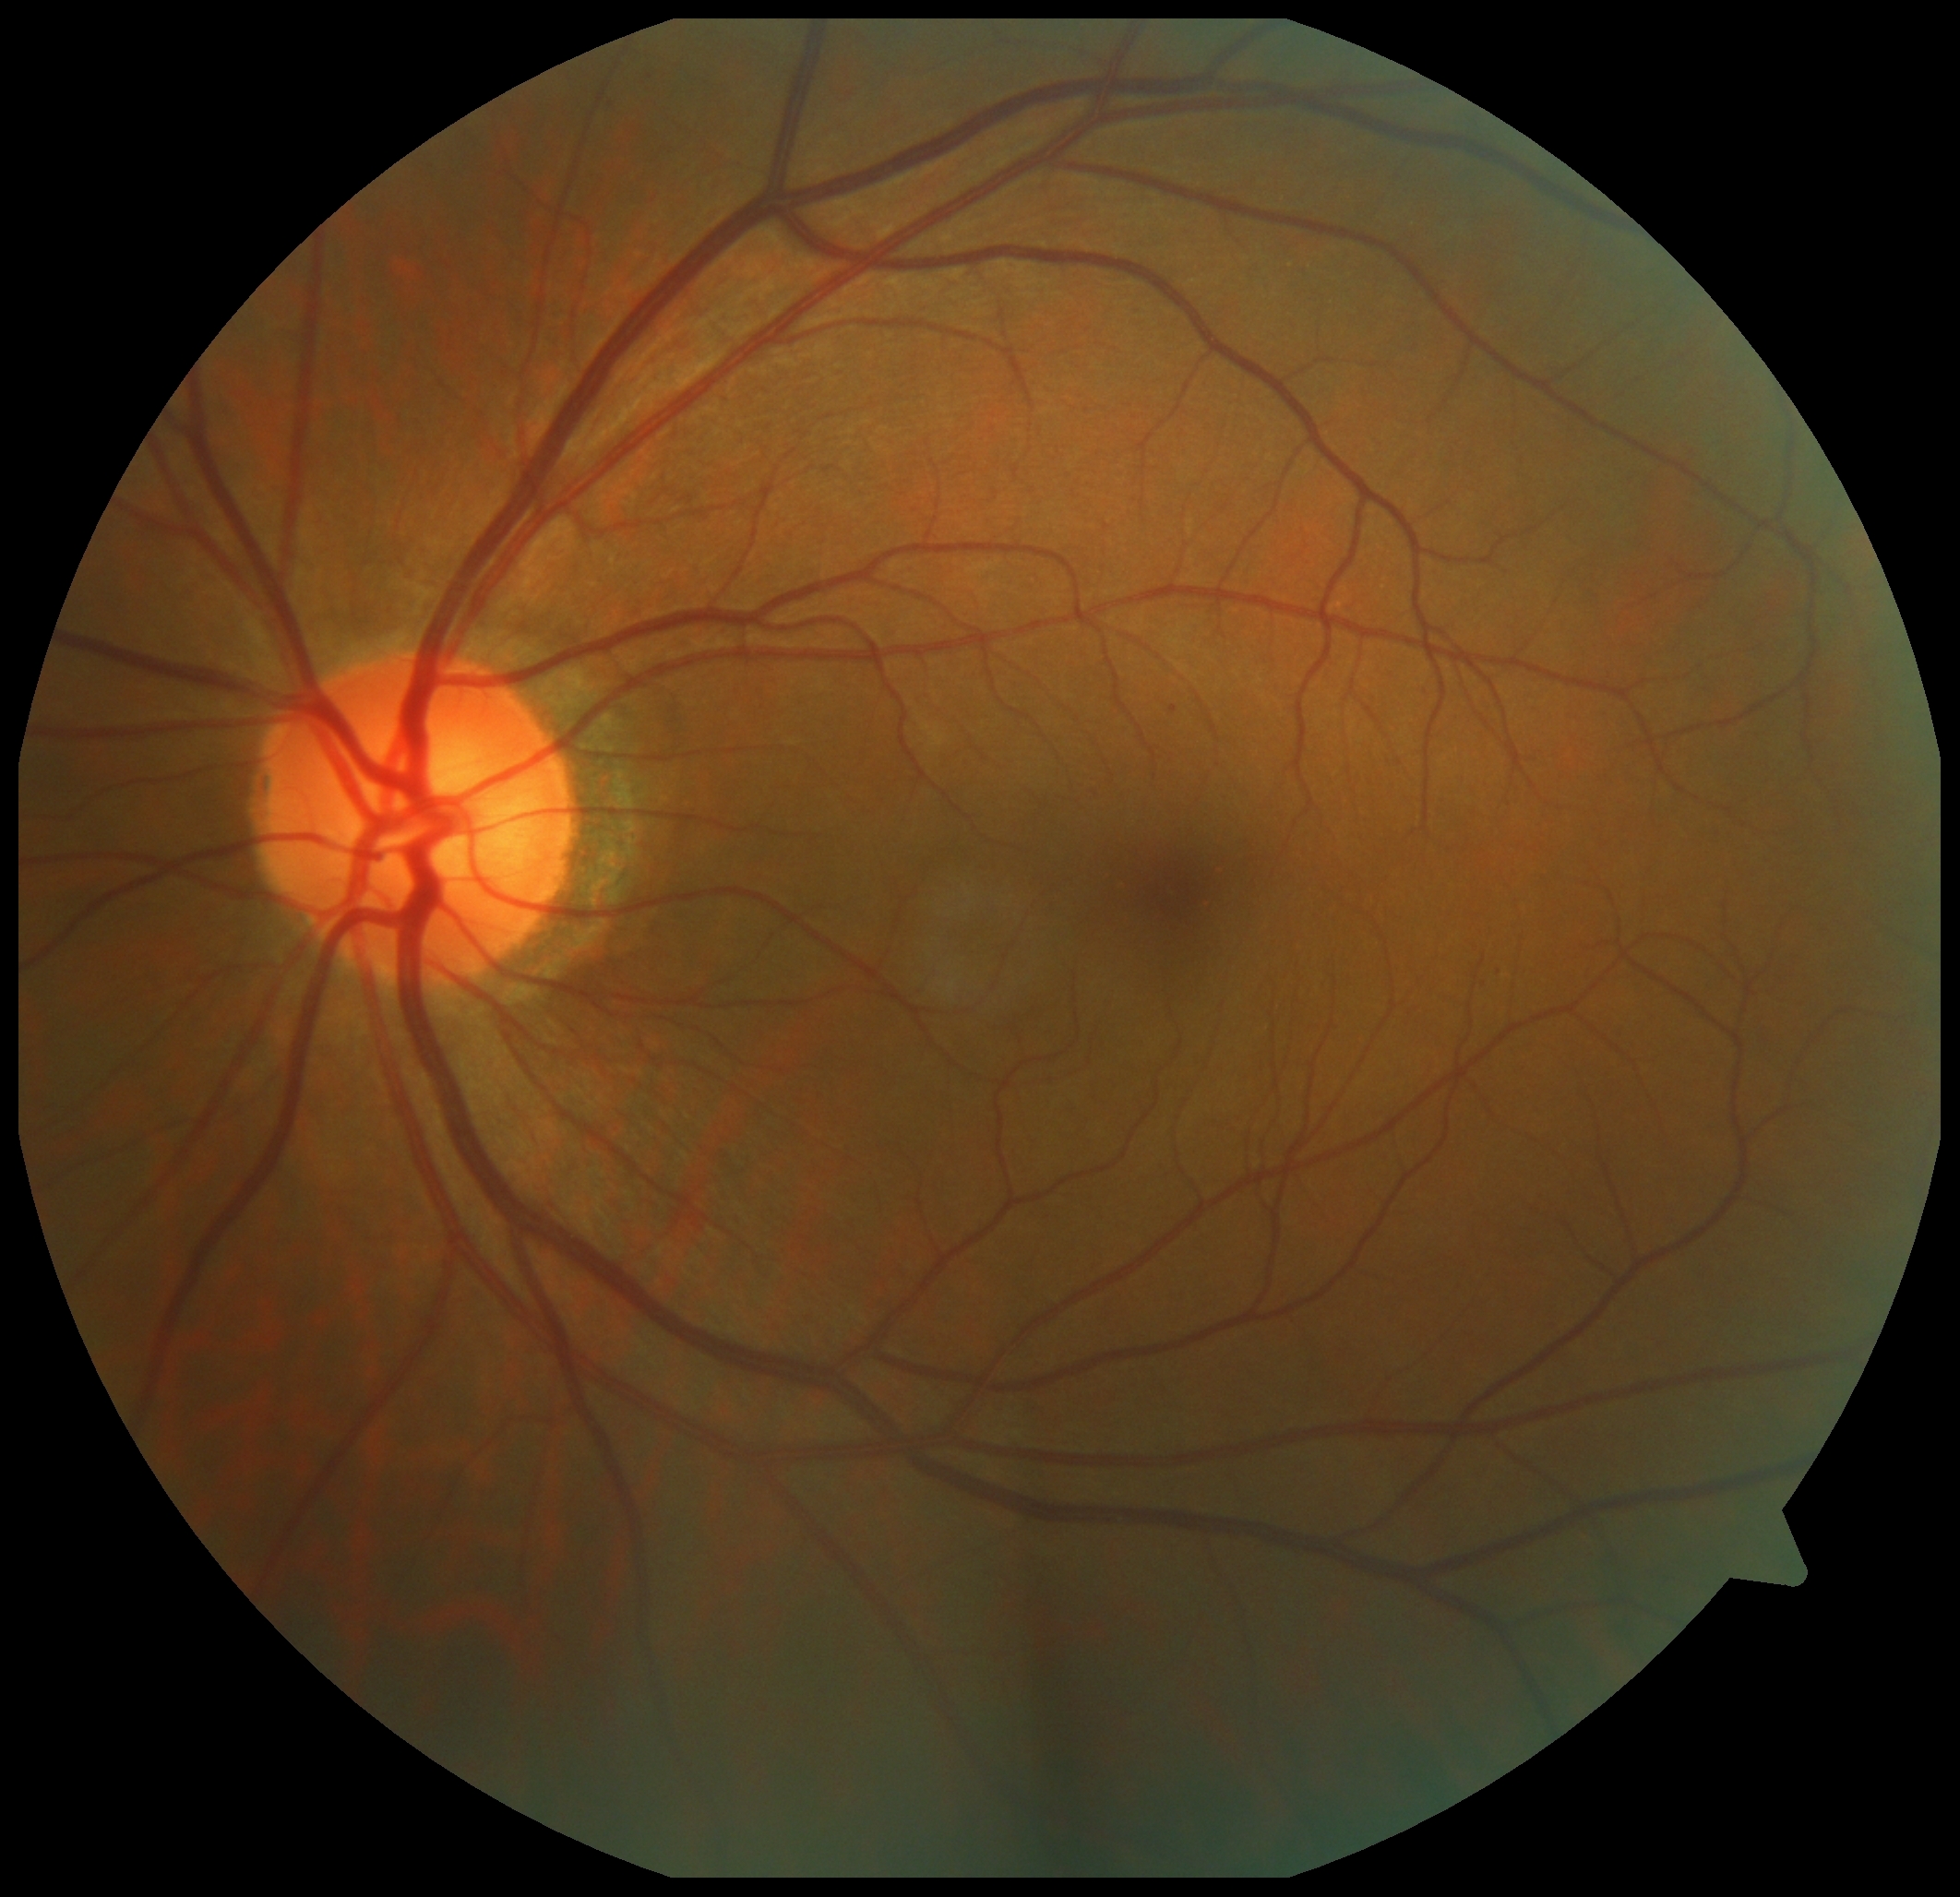 Diabetic retinopathy grade is 1 (mild NPDR).